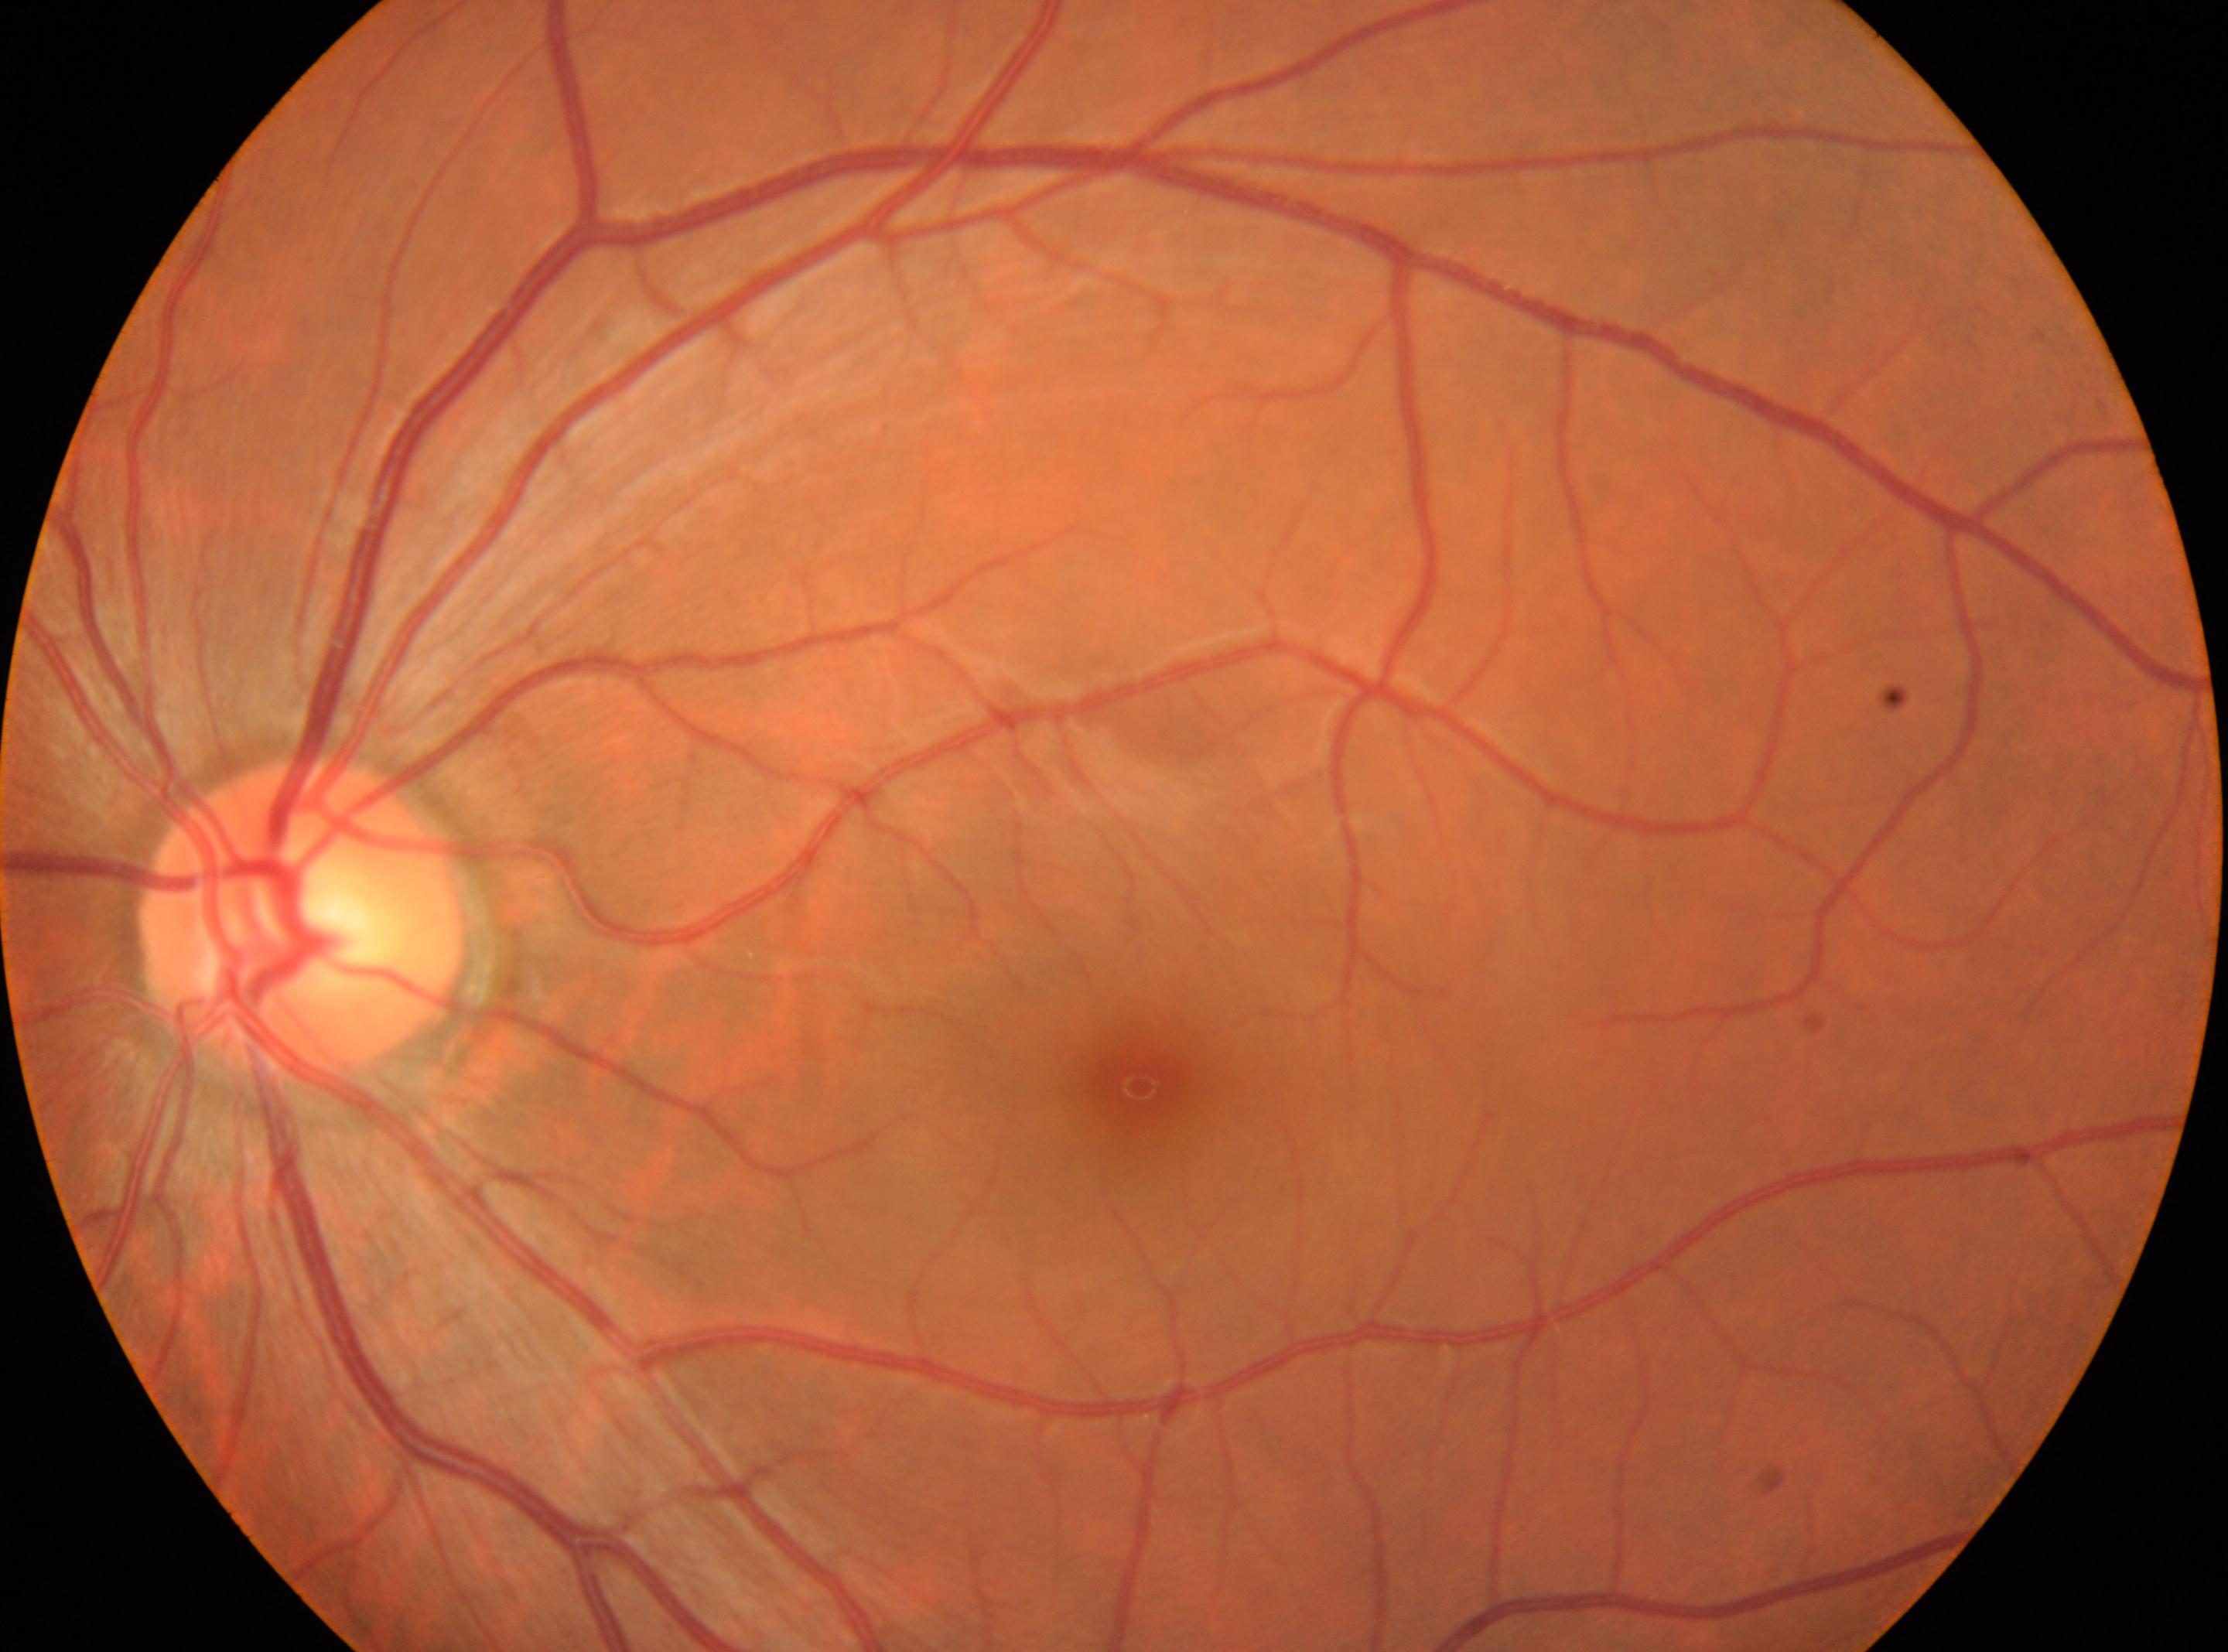

The macular center is at 1139, 1086. The image shows the left eye. Retinopathy grade is 0. ONH: 302, 919.